50° FOV.
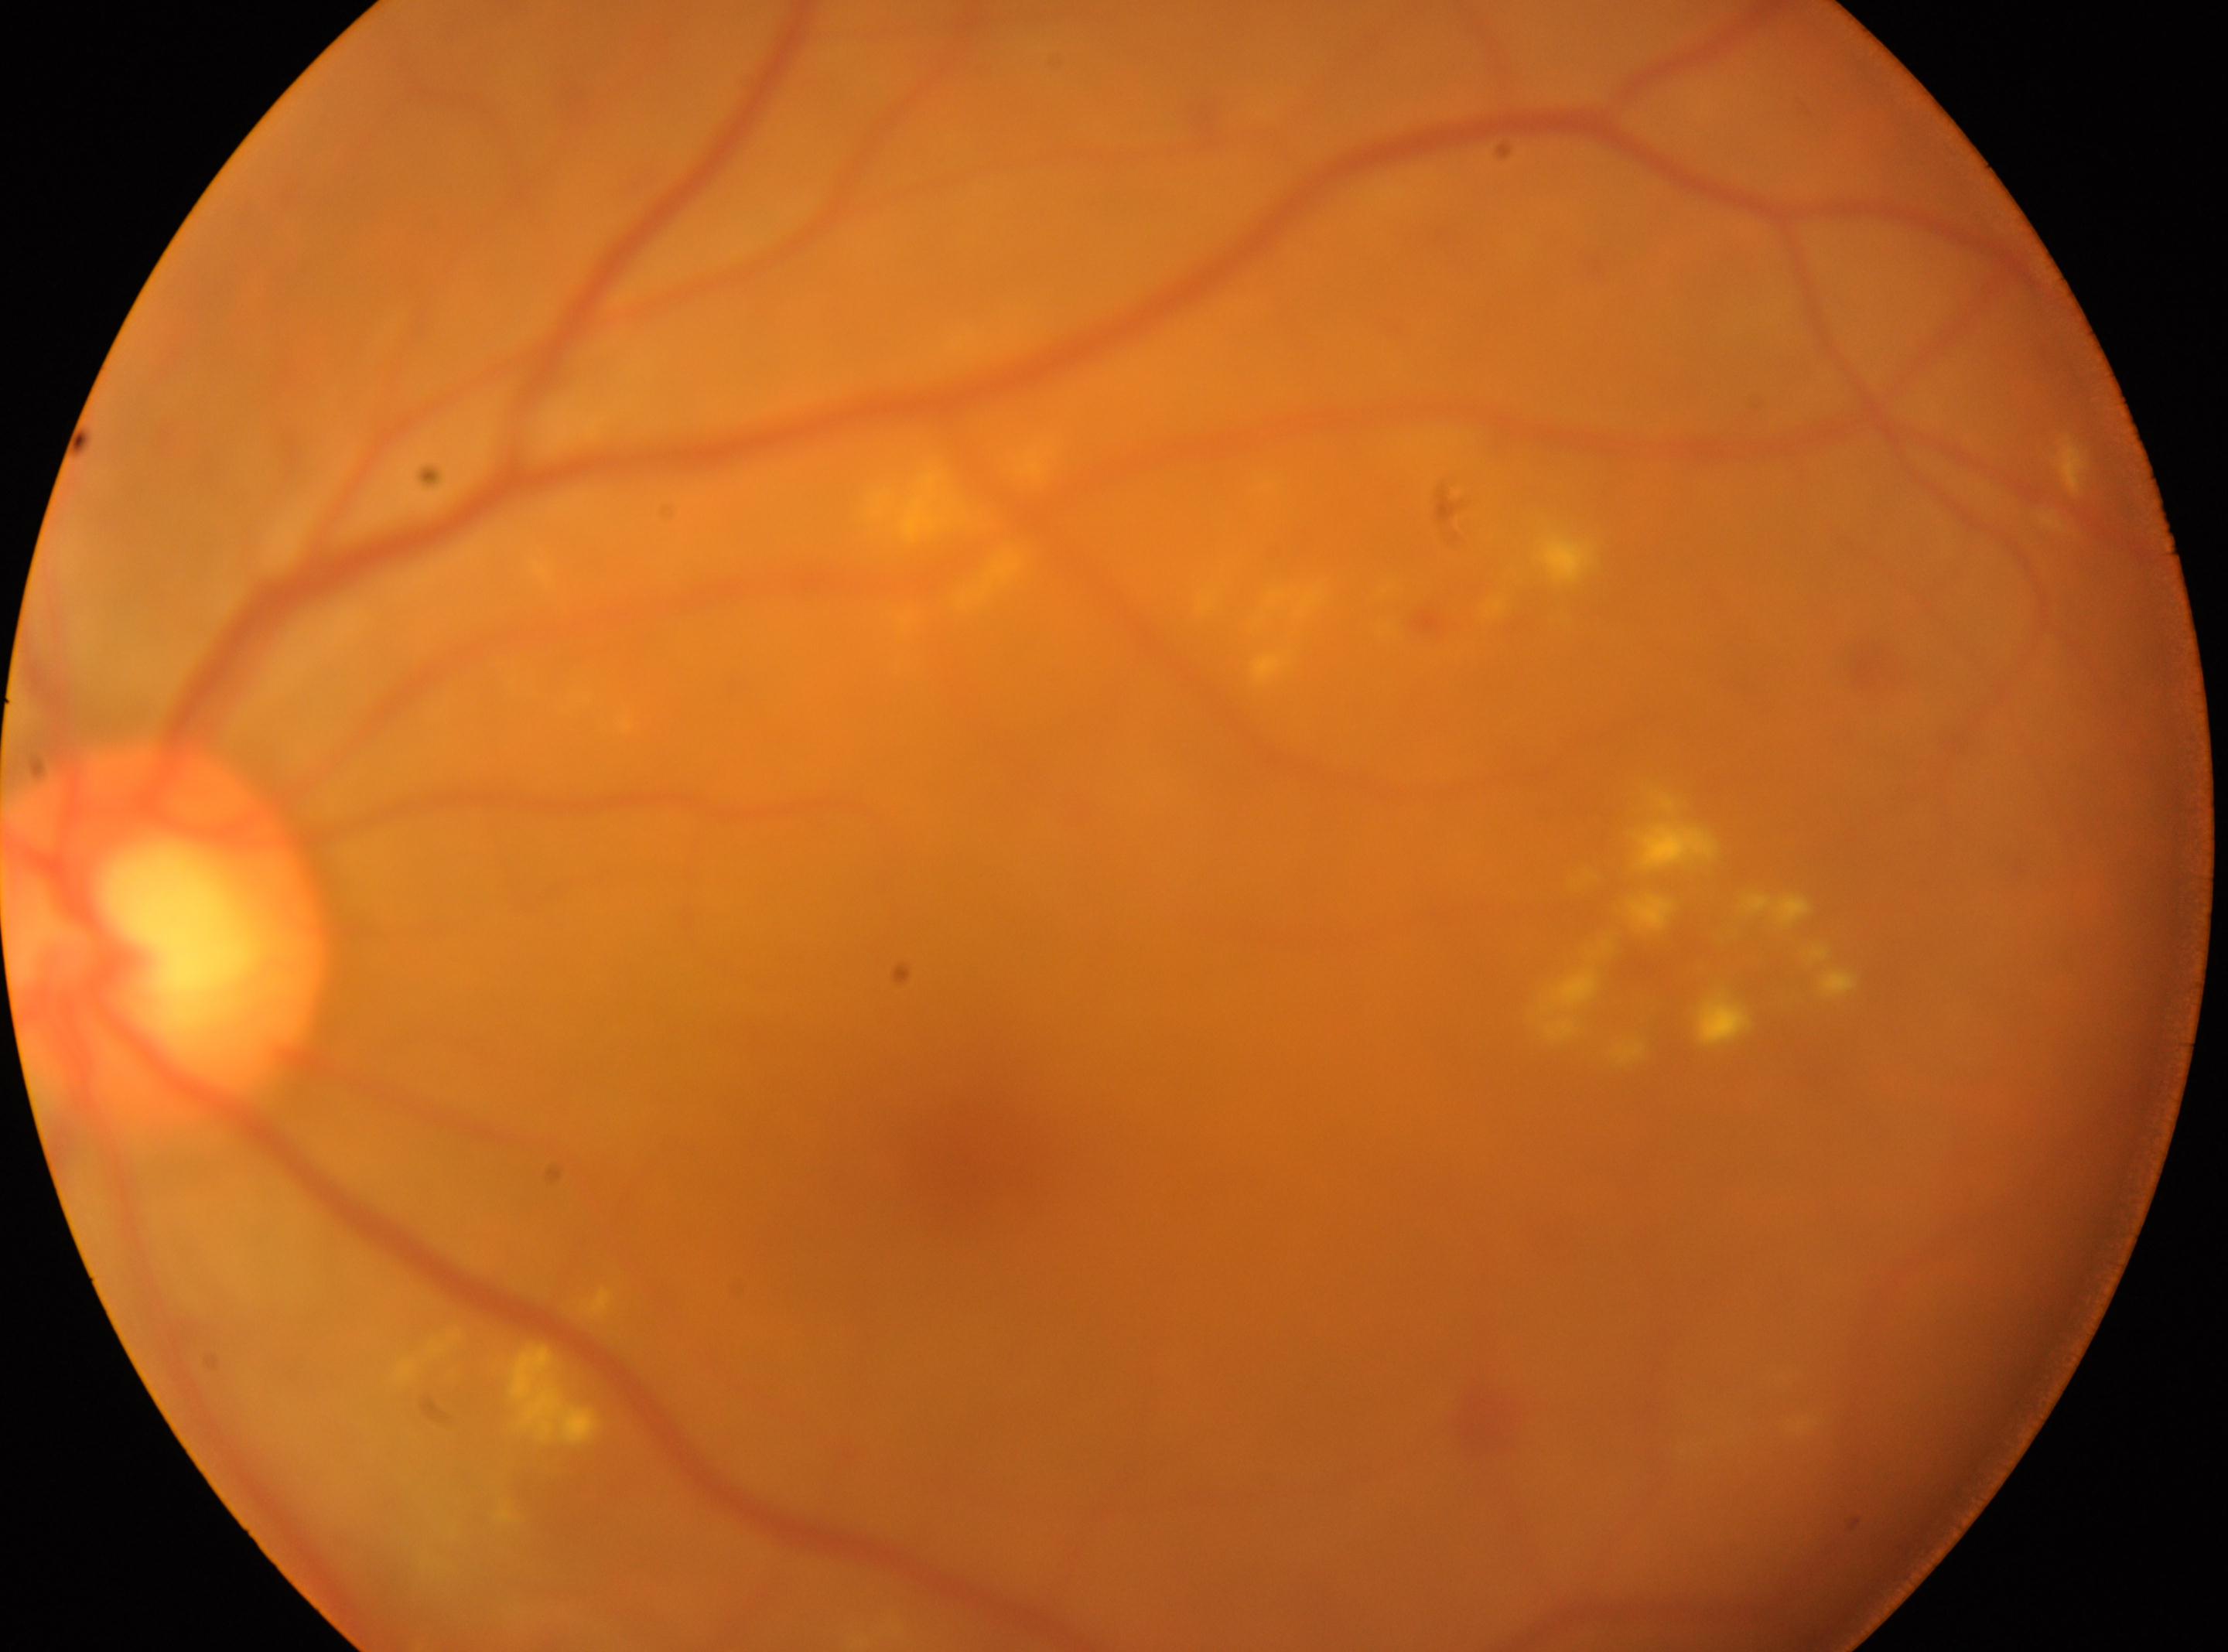

optic nerve head: (166,936); DR class: non-proliferative diabetic retinopathy; retinopathy: grade 2 (moderate NPDR); laterality: the left eye; fovea centralis: (958,1157).